Color fundus image, image size 848x848, NIDEK AFC-230 fundus camera — 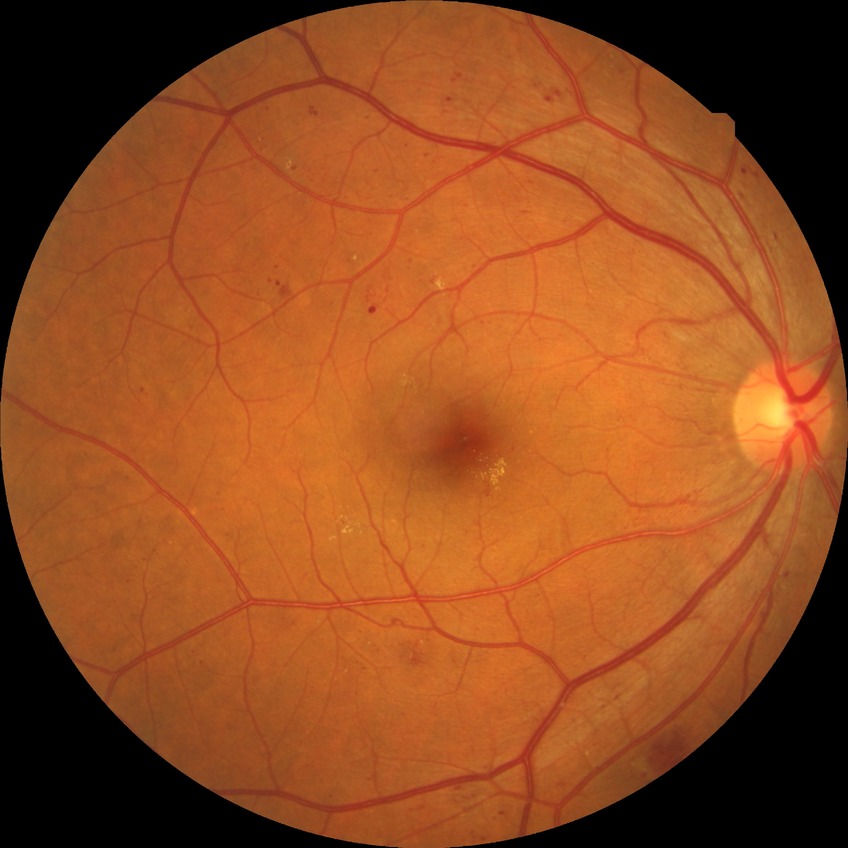

Annotations:
- diabetic retinopathy (DR) — SDR (simple diabetic retinopathy)